2212 x 1659 pixels
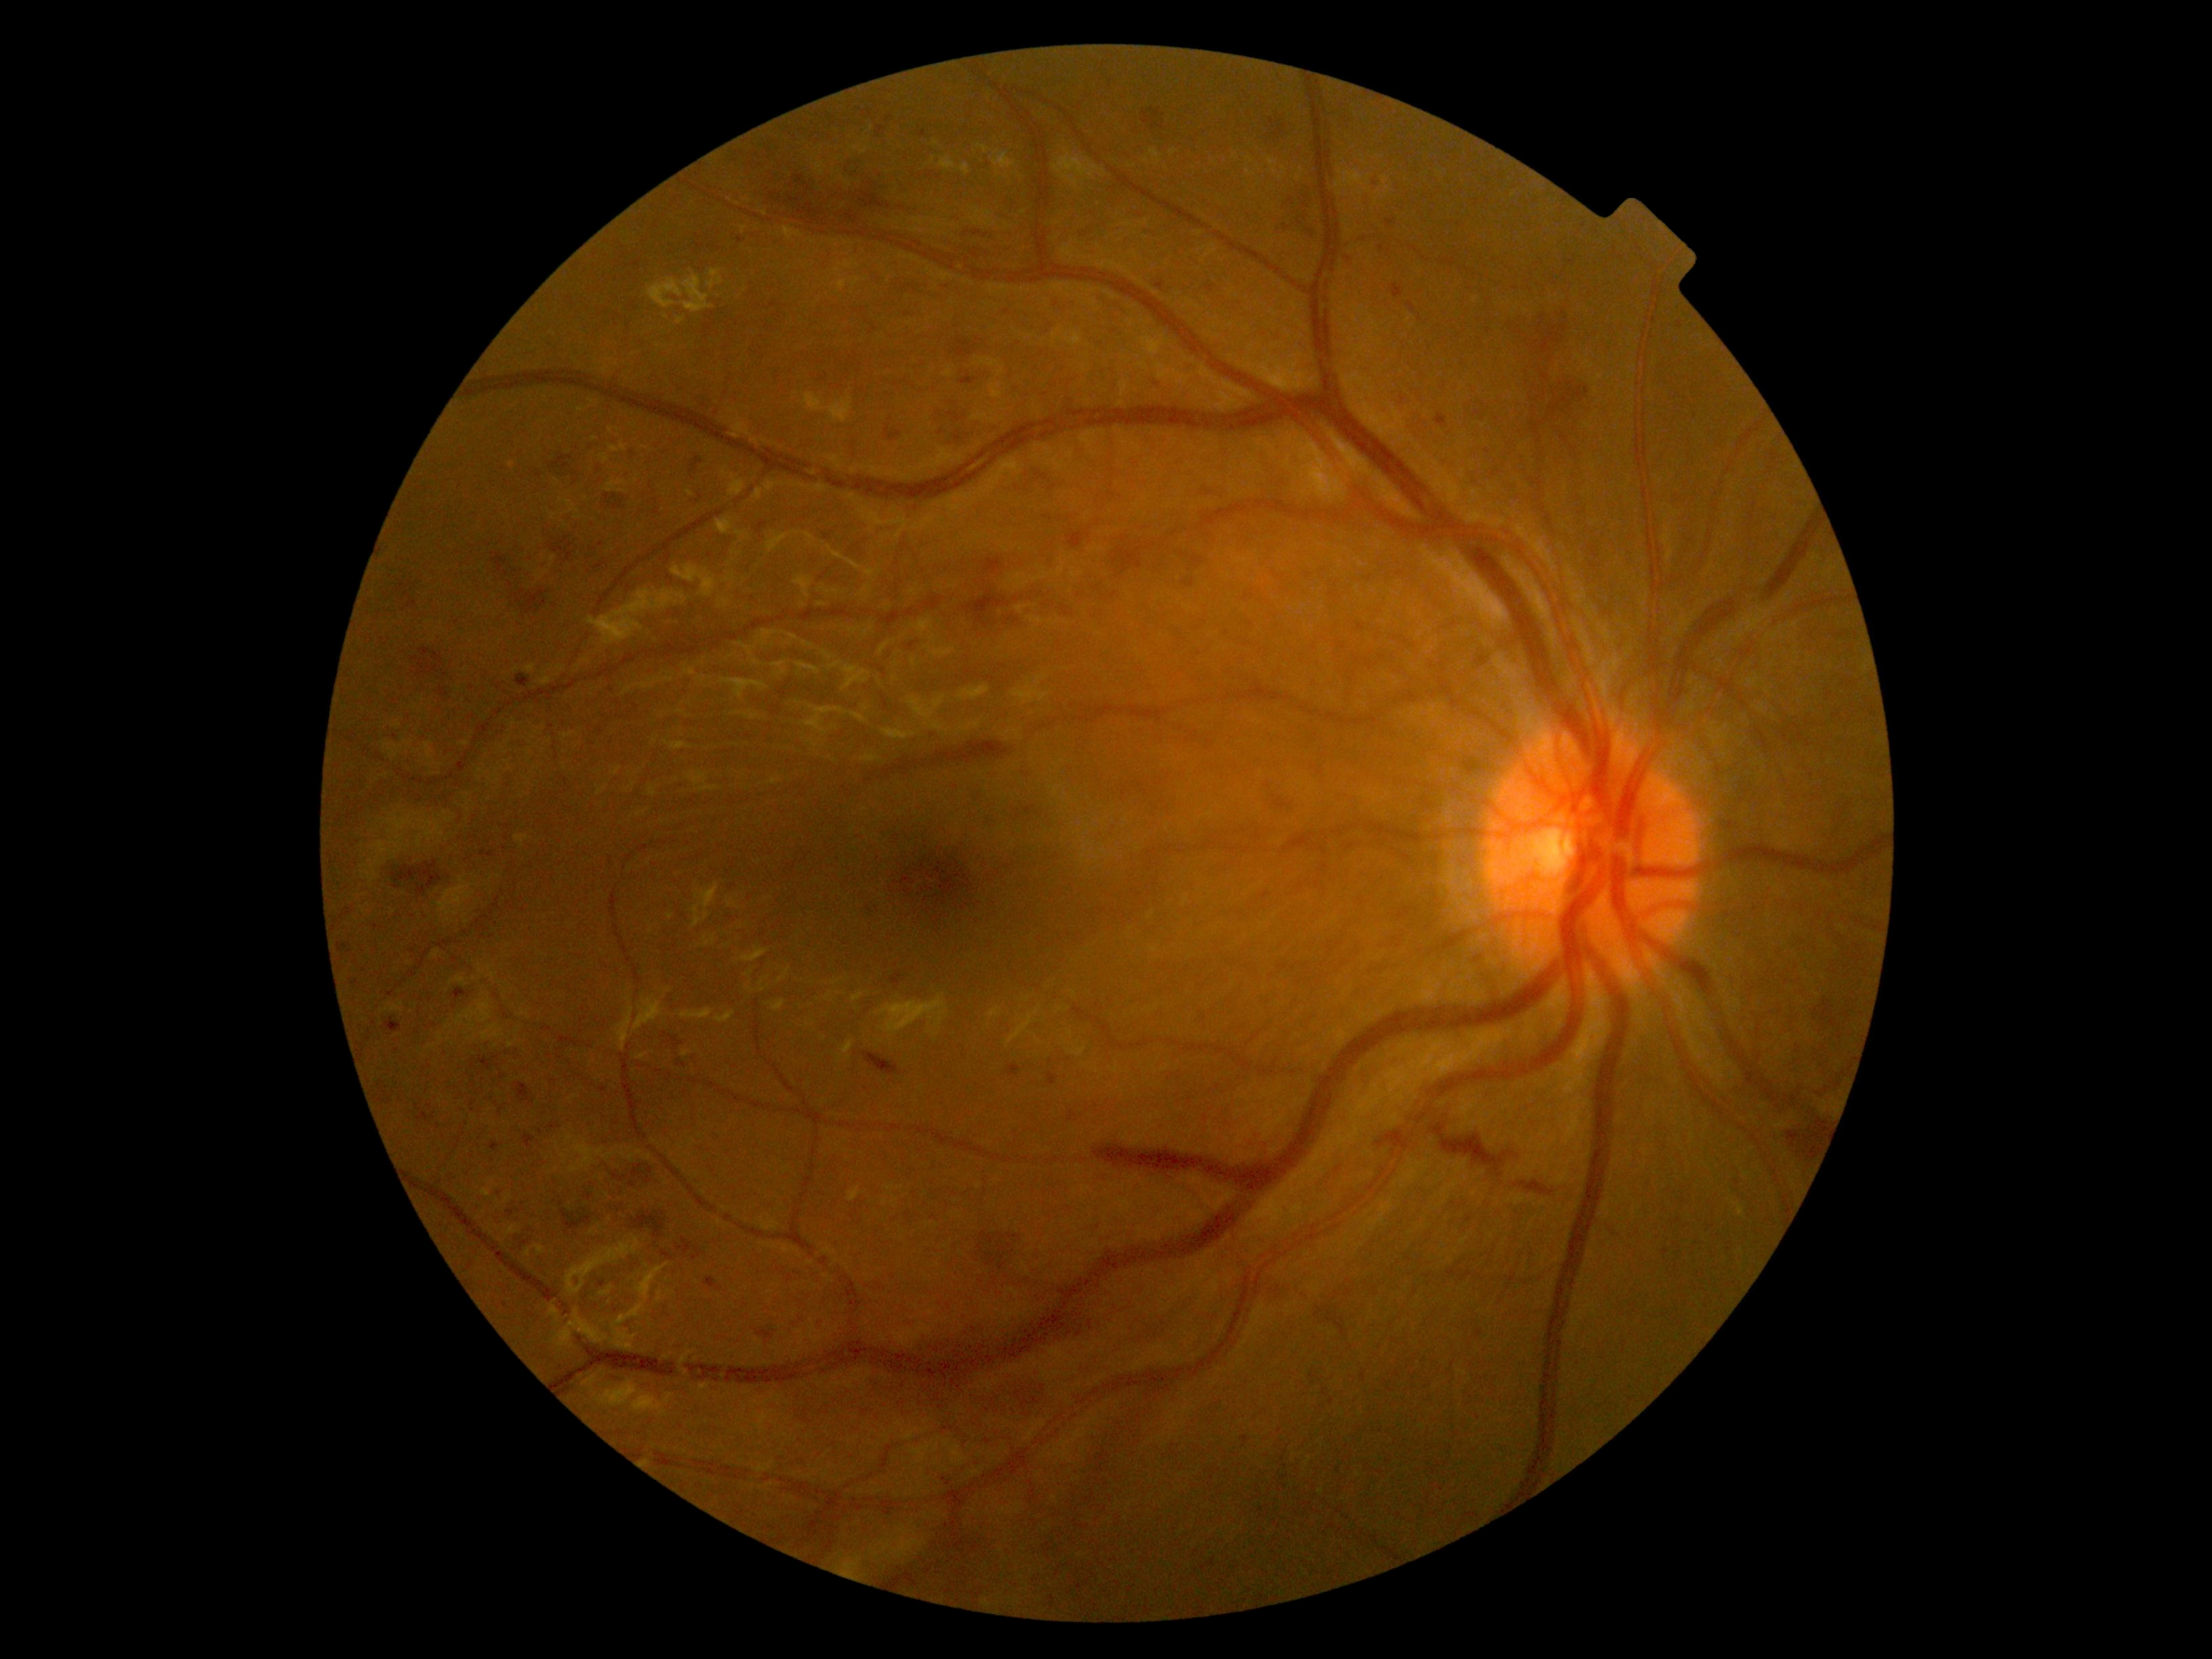 Diabetic retinopathy (DR) is grade 3. Hemorrhages (HEs) are present, including at 841, 162, 867, 182; 693, 1248, 704, 1260; 1067, 532, 1090, 548; 959, 376, 978, 386; 1661, 1249, 1669, 1257; 1113, 537, 1150, 578; 676, 1238, 692, 1253; 341, 909, 353, 918; 1142, 105, 1170, 135; 823, 535, 832, 540; 758, 521, 766, 533; 1431, 1123, 1515, 1177; 479, 1057, 493, 1070. Smaller HEs around pt(561, 1204); pt(1348, 259); pt(1382, 248); pt(968, 232); pt(568, 1312); pt(891, 419).